Color fundus photograph
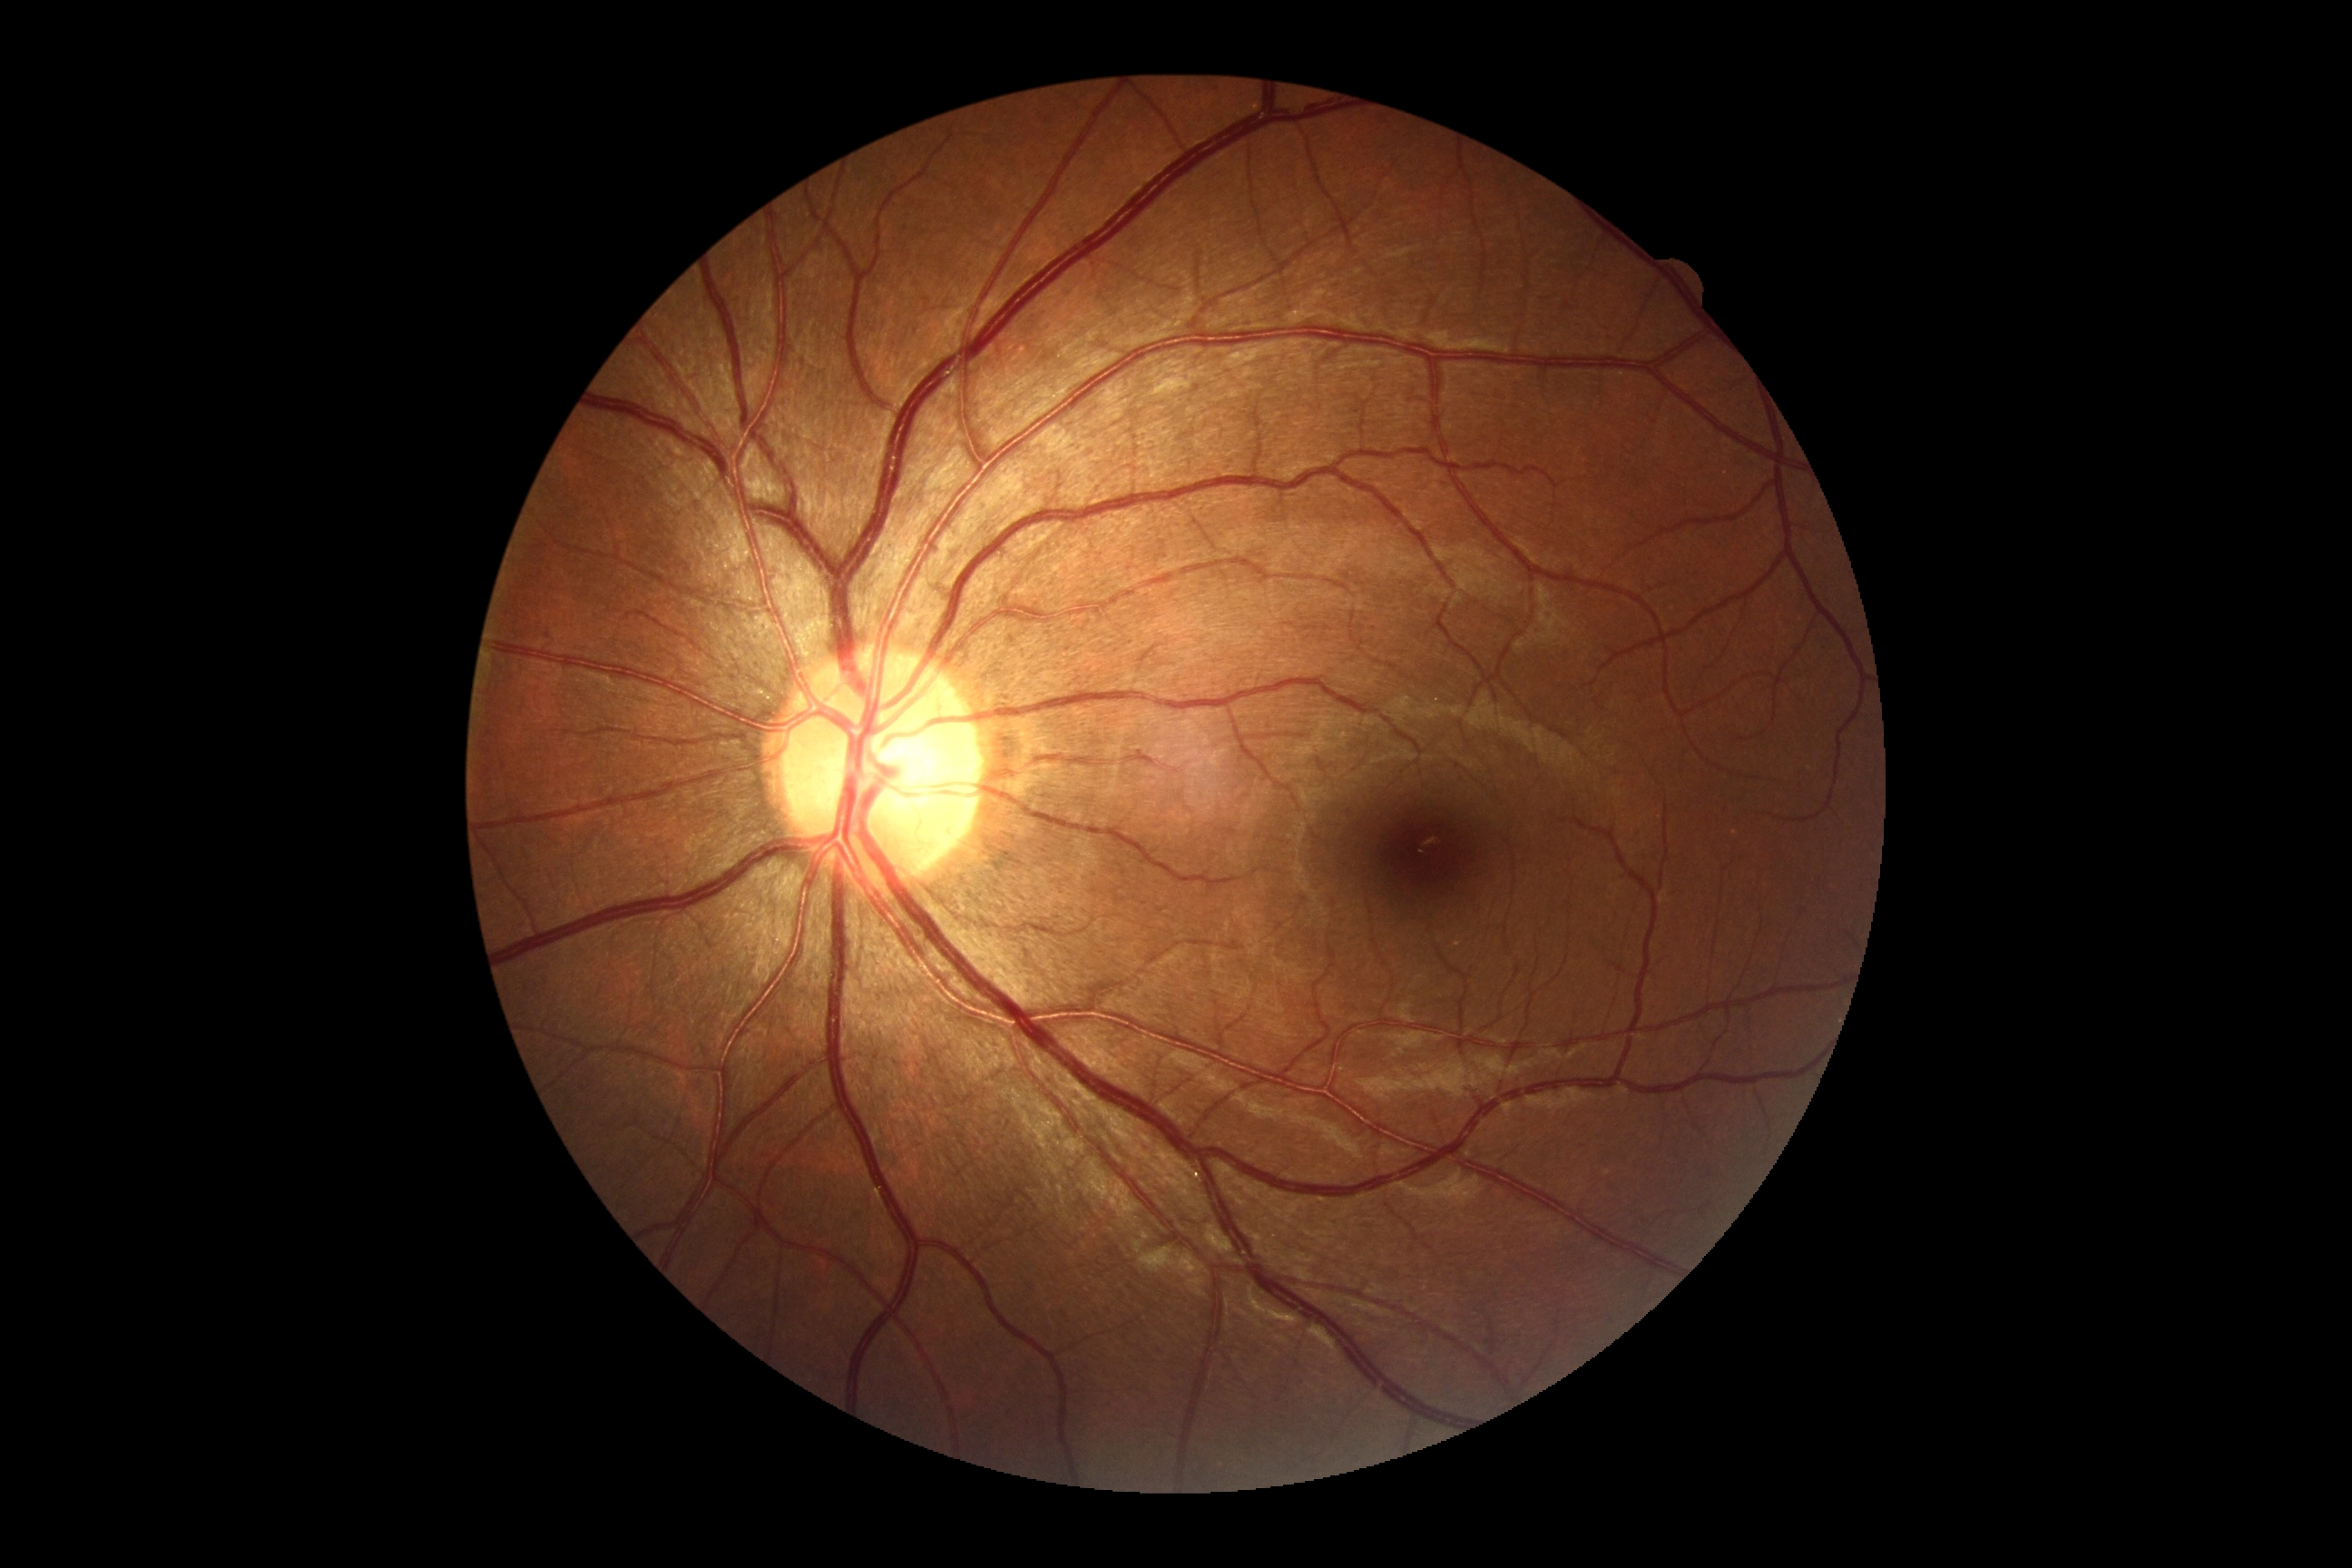 No diabetic retinal disease findings.
Retinopathy grade is no apparent diabetic retinopathy (0) — no visible signs of diabetic retinopathy.